Wide-field fundus image from infant ROP screening
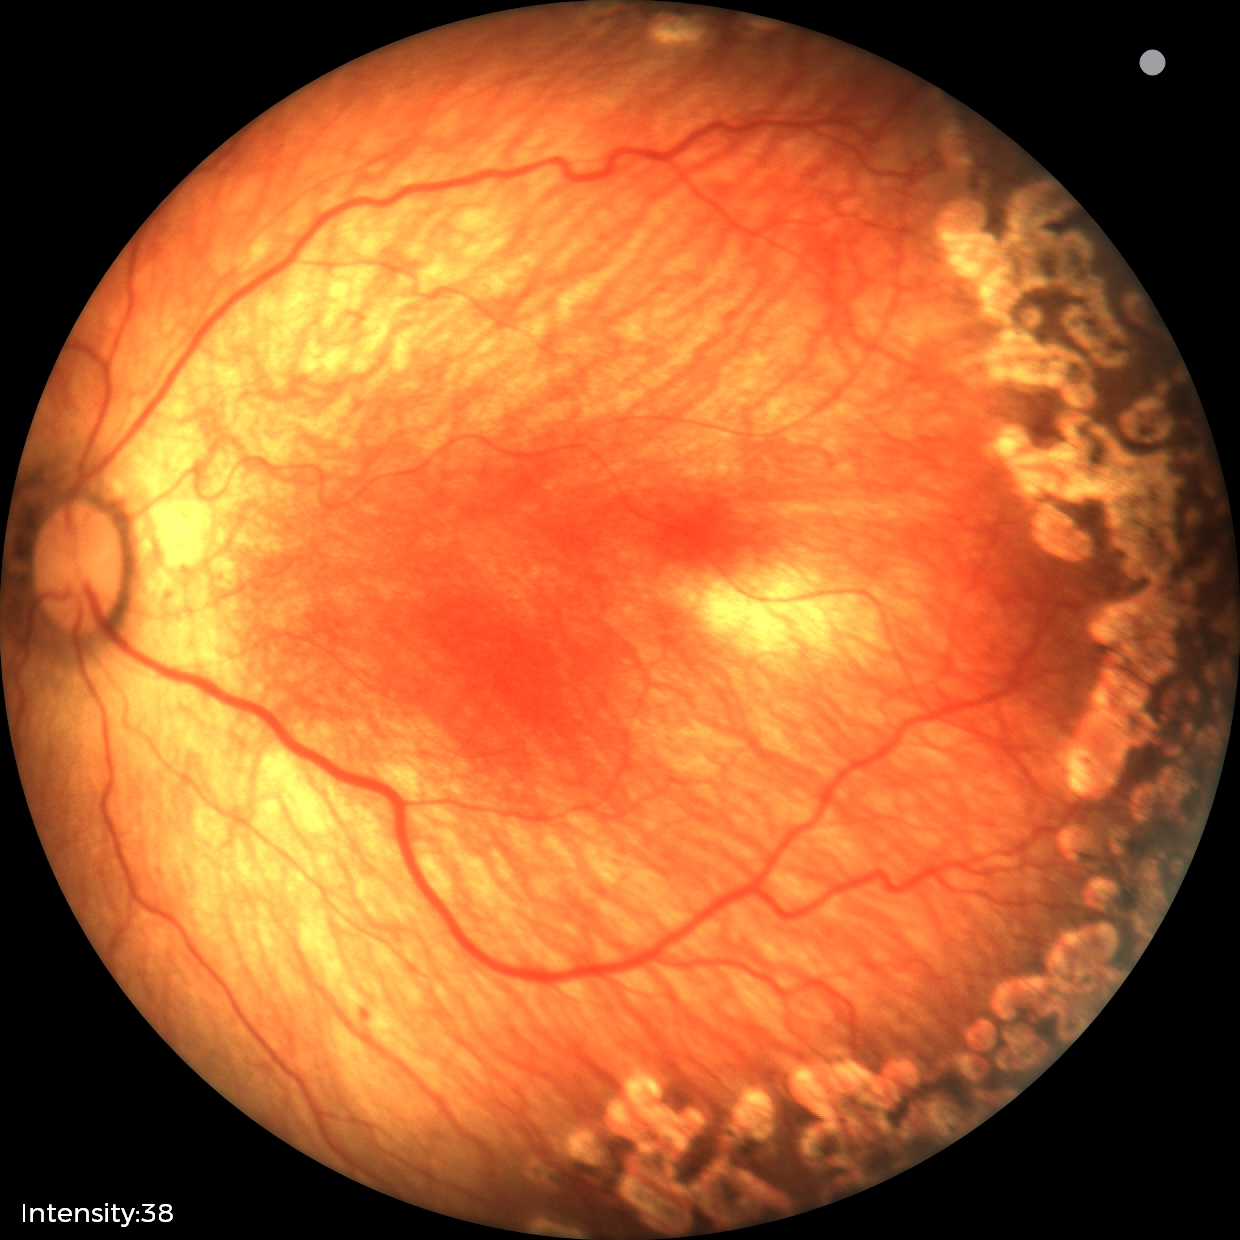 Plus disease absent. Series diagnosed as status post ROP — retinal appearance after treated retinopathy of prematurity.